Color fundus image
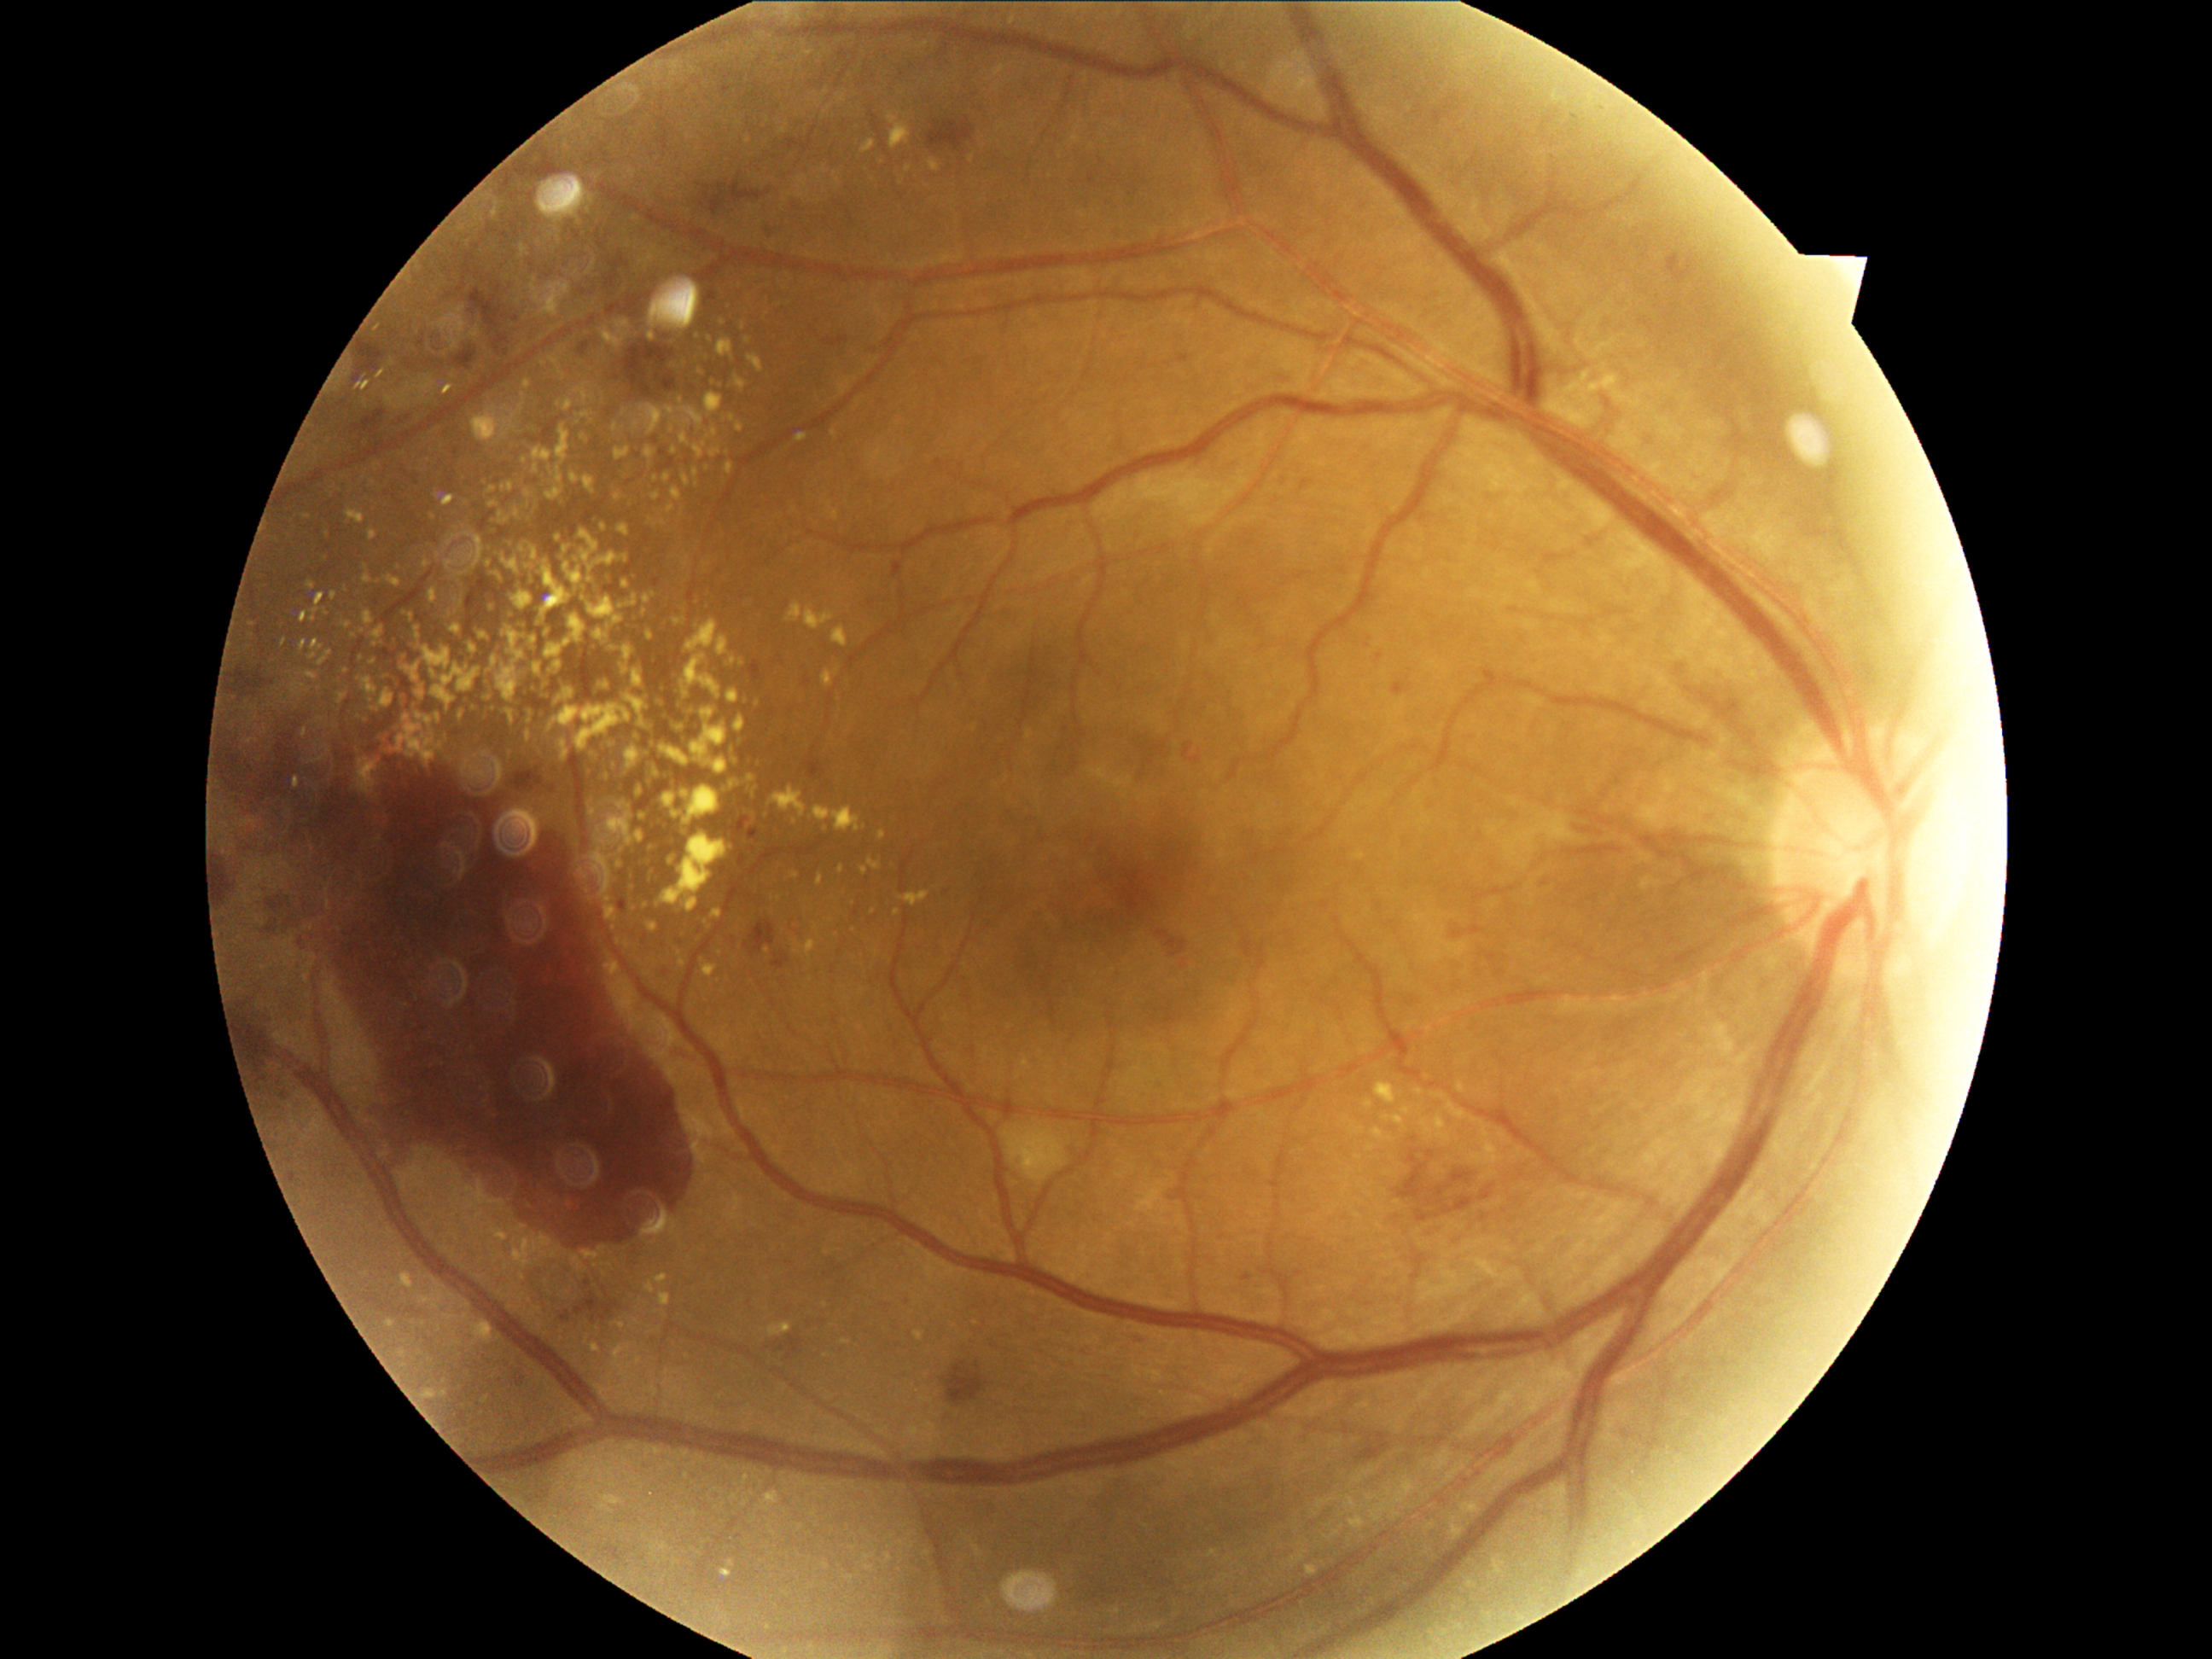

Diabetic retinopathy (DR) is grade 4 (PDR)
Representative lesions:
- hard exudates (EXs) (partial): box(684, 655, 721, 699) | box(728, 689, 747, 704) | box(480, 692, 494, 701) | box(644, 465, 653, 472) | box(564, 540, 579, 554) | box(545, 641, 573, 660) | box(586, 772, 597, 777) | box(672, 786, 680, 791) | box(556, 467, 564, 484) | box(591, 1344, 600, 1353) | box(728, 463, 735, 474) | box(535, 479, 544, 489)
- Additional small EXs near [685, 803] | [623, 1326] | [678, 622] | [733, 661] | [496, 712] | [524, 672] | [636, 627]